RetCam wide-field infant fundus image; 130° field of view (Natus RetCam Envision) — 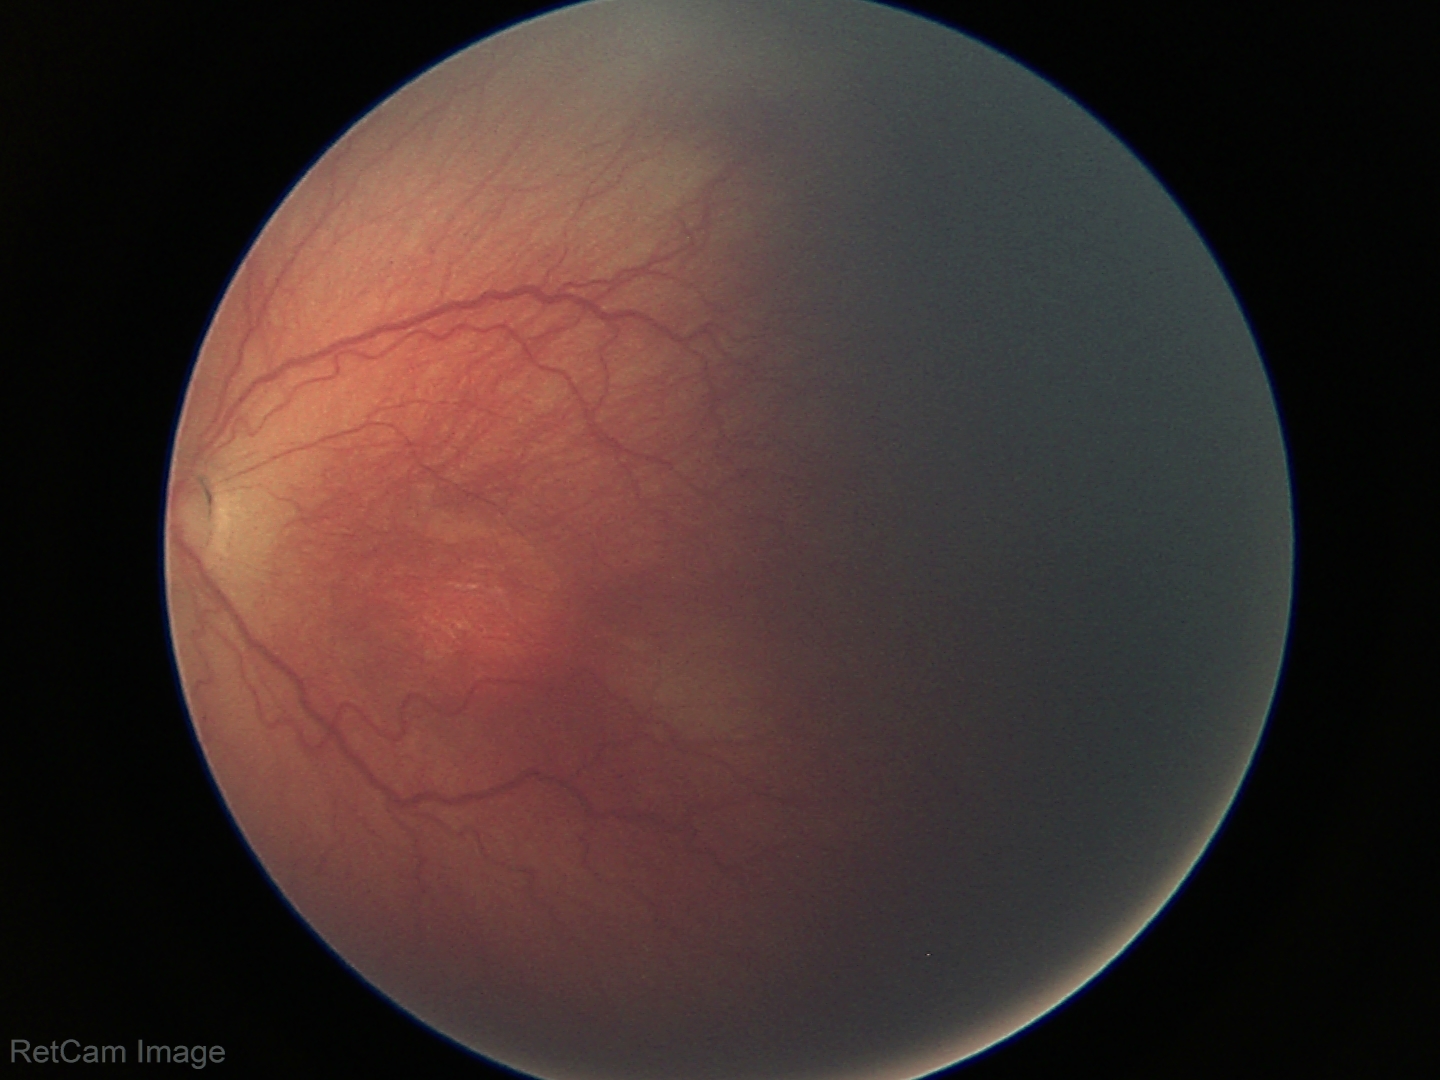
Without plus disease. Diagnosis from this screening exam: retinopathy of prematurity (ROP) stage 2.